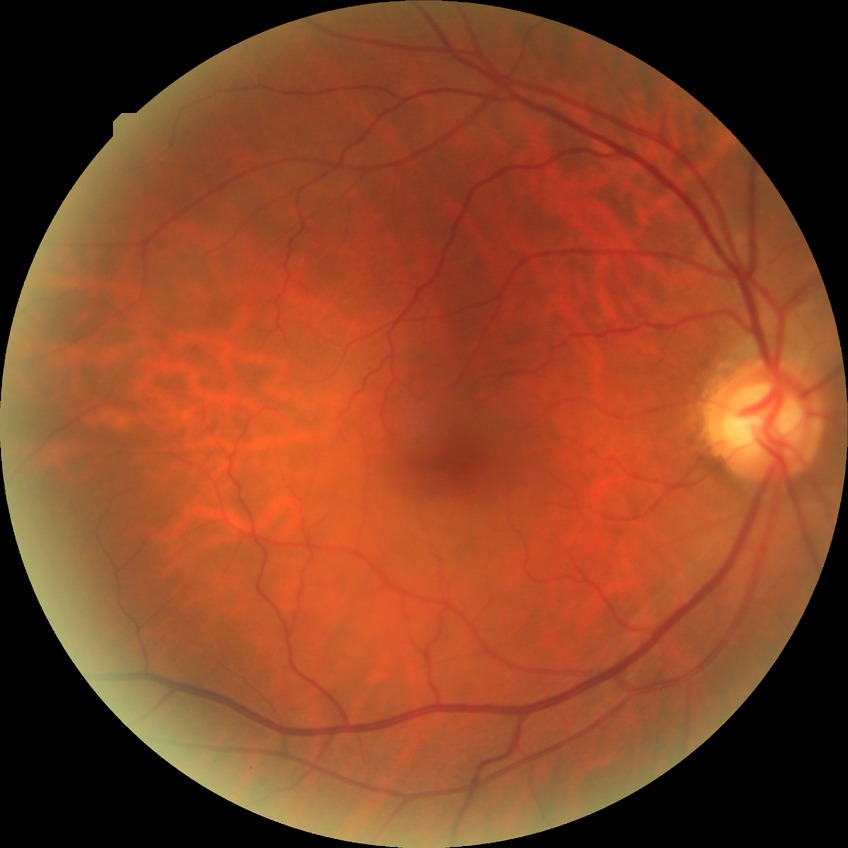
DR grade: NDR.